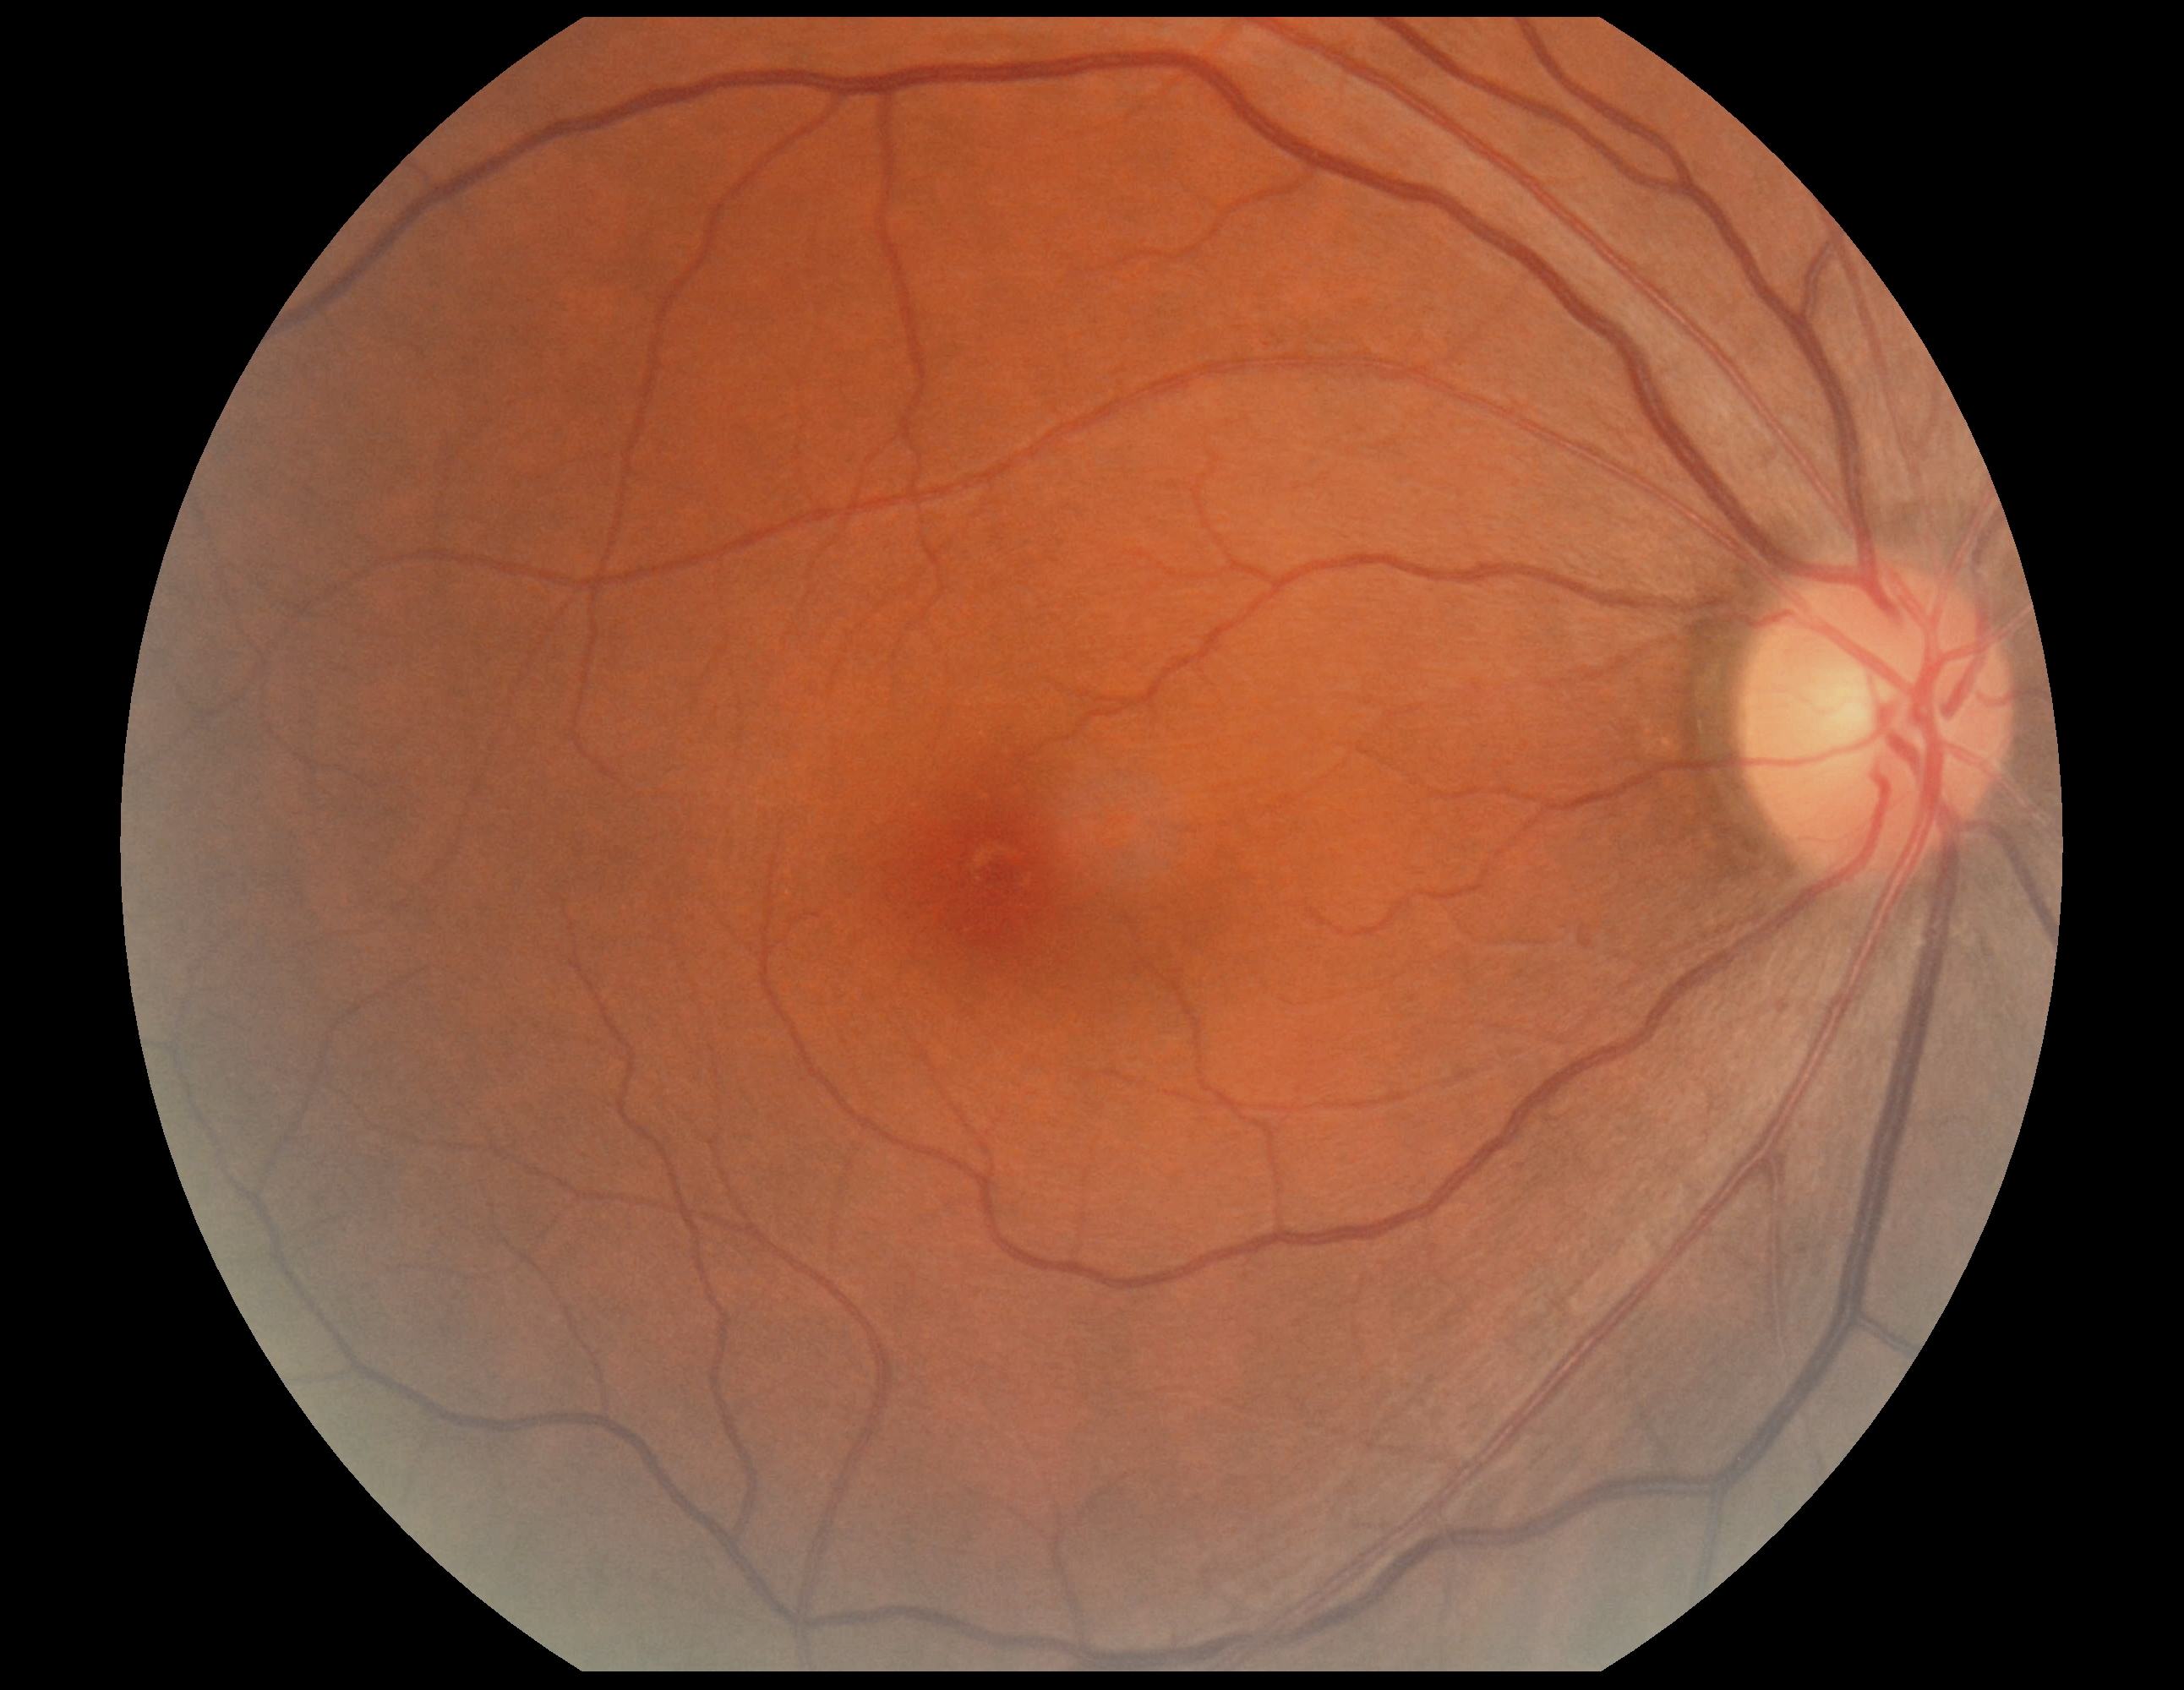

No signs of diabetic retinopathy.
Diabetic retinopathy: grade 0 (no apparent retinopathy).